Captured without pupil dilation.
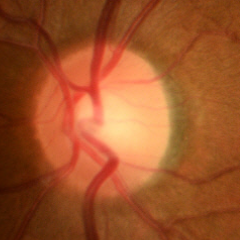

Fundus appearance consistent with no glaucomatous optic neuropathy.